848 by 848 pixels, 45° field of view, color fundus photograph, acquired with a NIDEK AFC-230, nonmydriatic
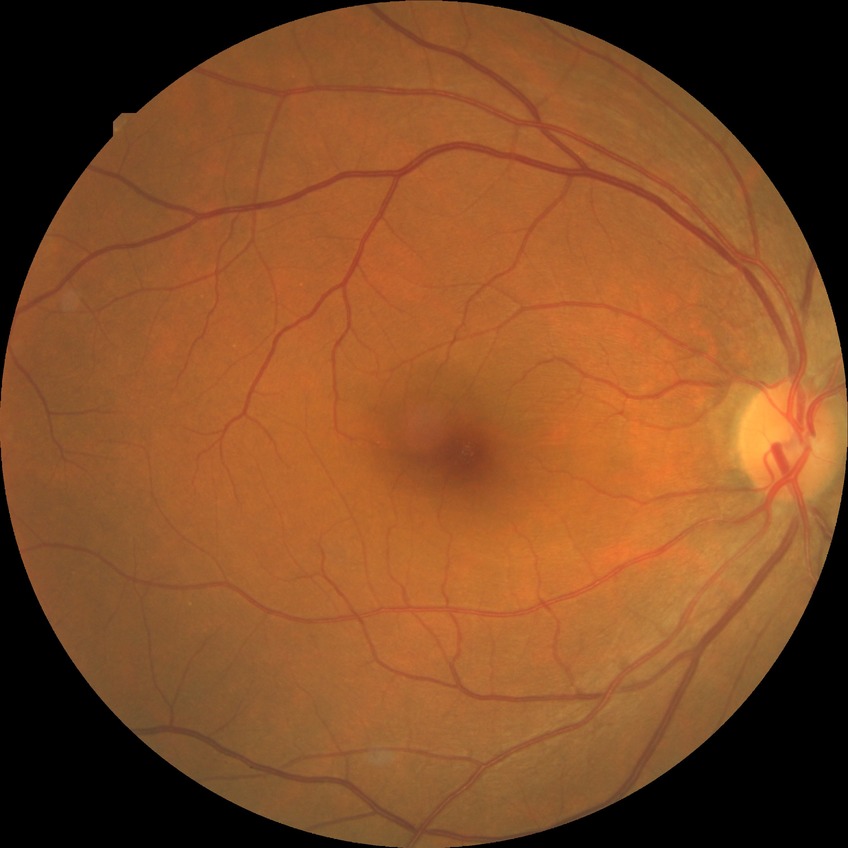
Diabetic retinopathy stage: no diabetic retinopathy.